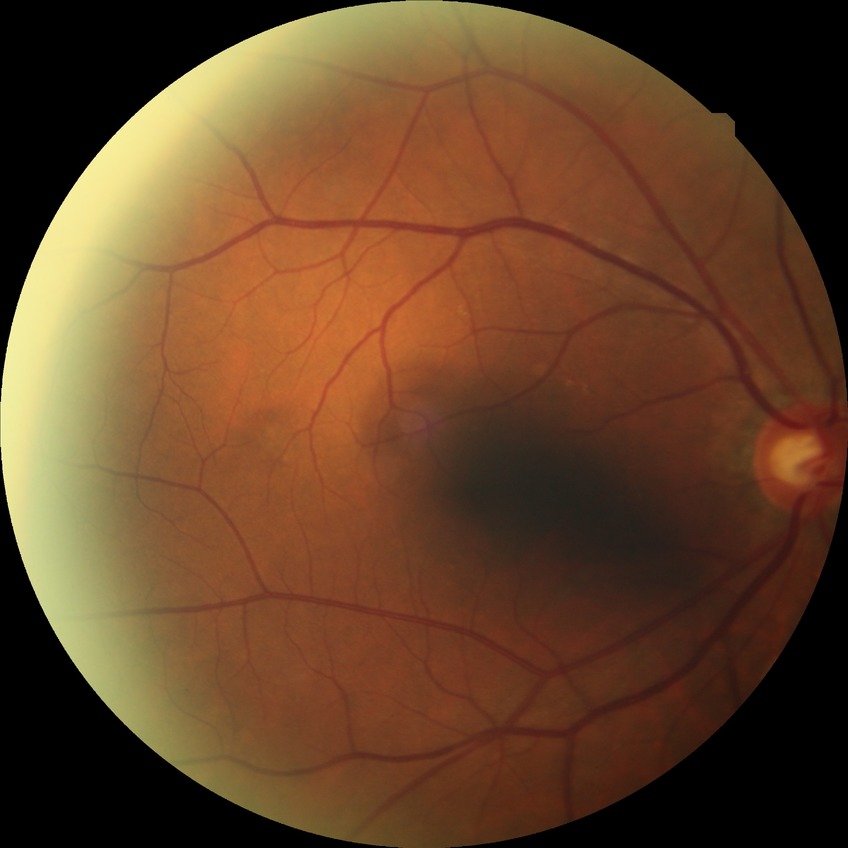

diabetic retinopathy (DR): NDR (no diabetic retinopathy)